Acquired with a Nidek AFC-330. 240x240
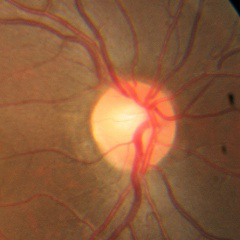

No glaucomatous changes.